FOV: 45 degrees:
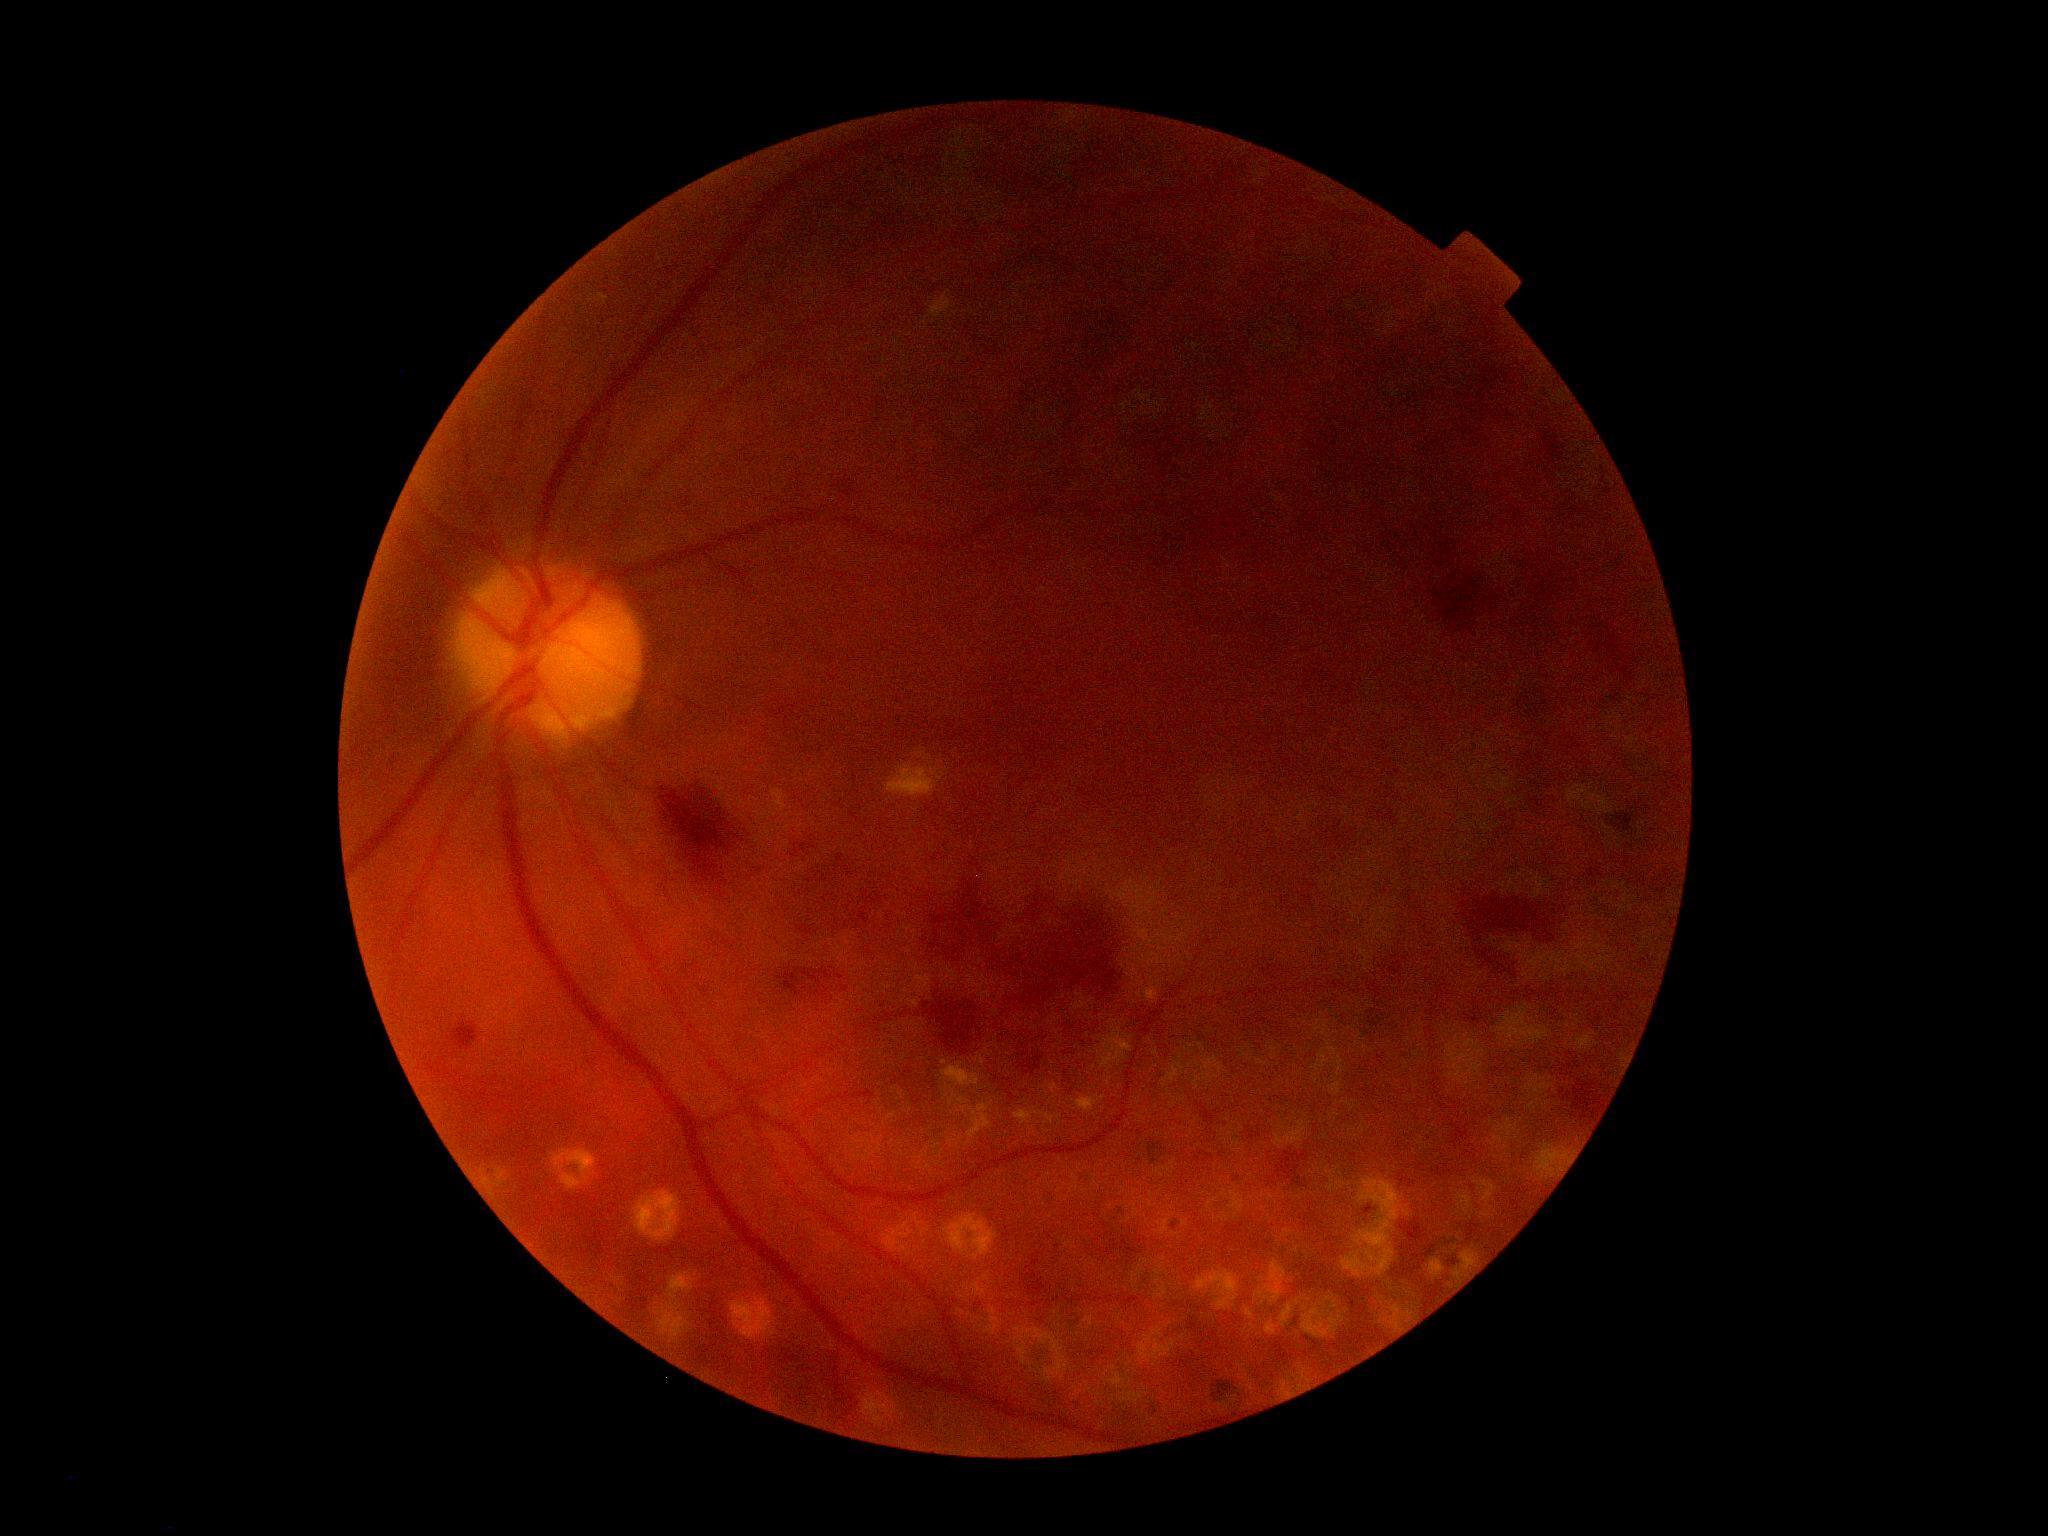   dr_category: non-proliferative diabetic retinopathy
  dr_grade: moderate non-proliferative diabetic retinopathy (grade 2)